Camera: Topcon TRC-NW400; 30° FOV; 2212 by 1661 pixels; optic disc at the center of the field; CFP — 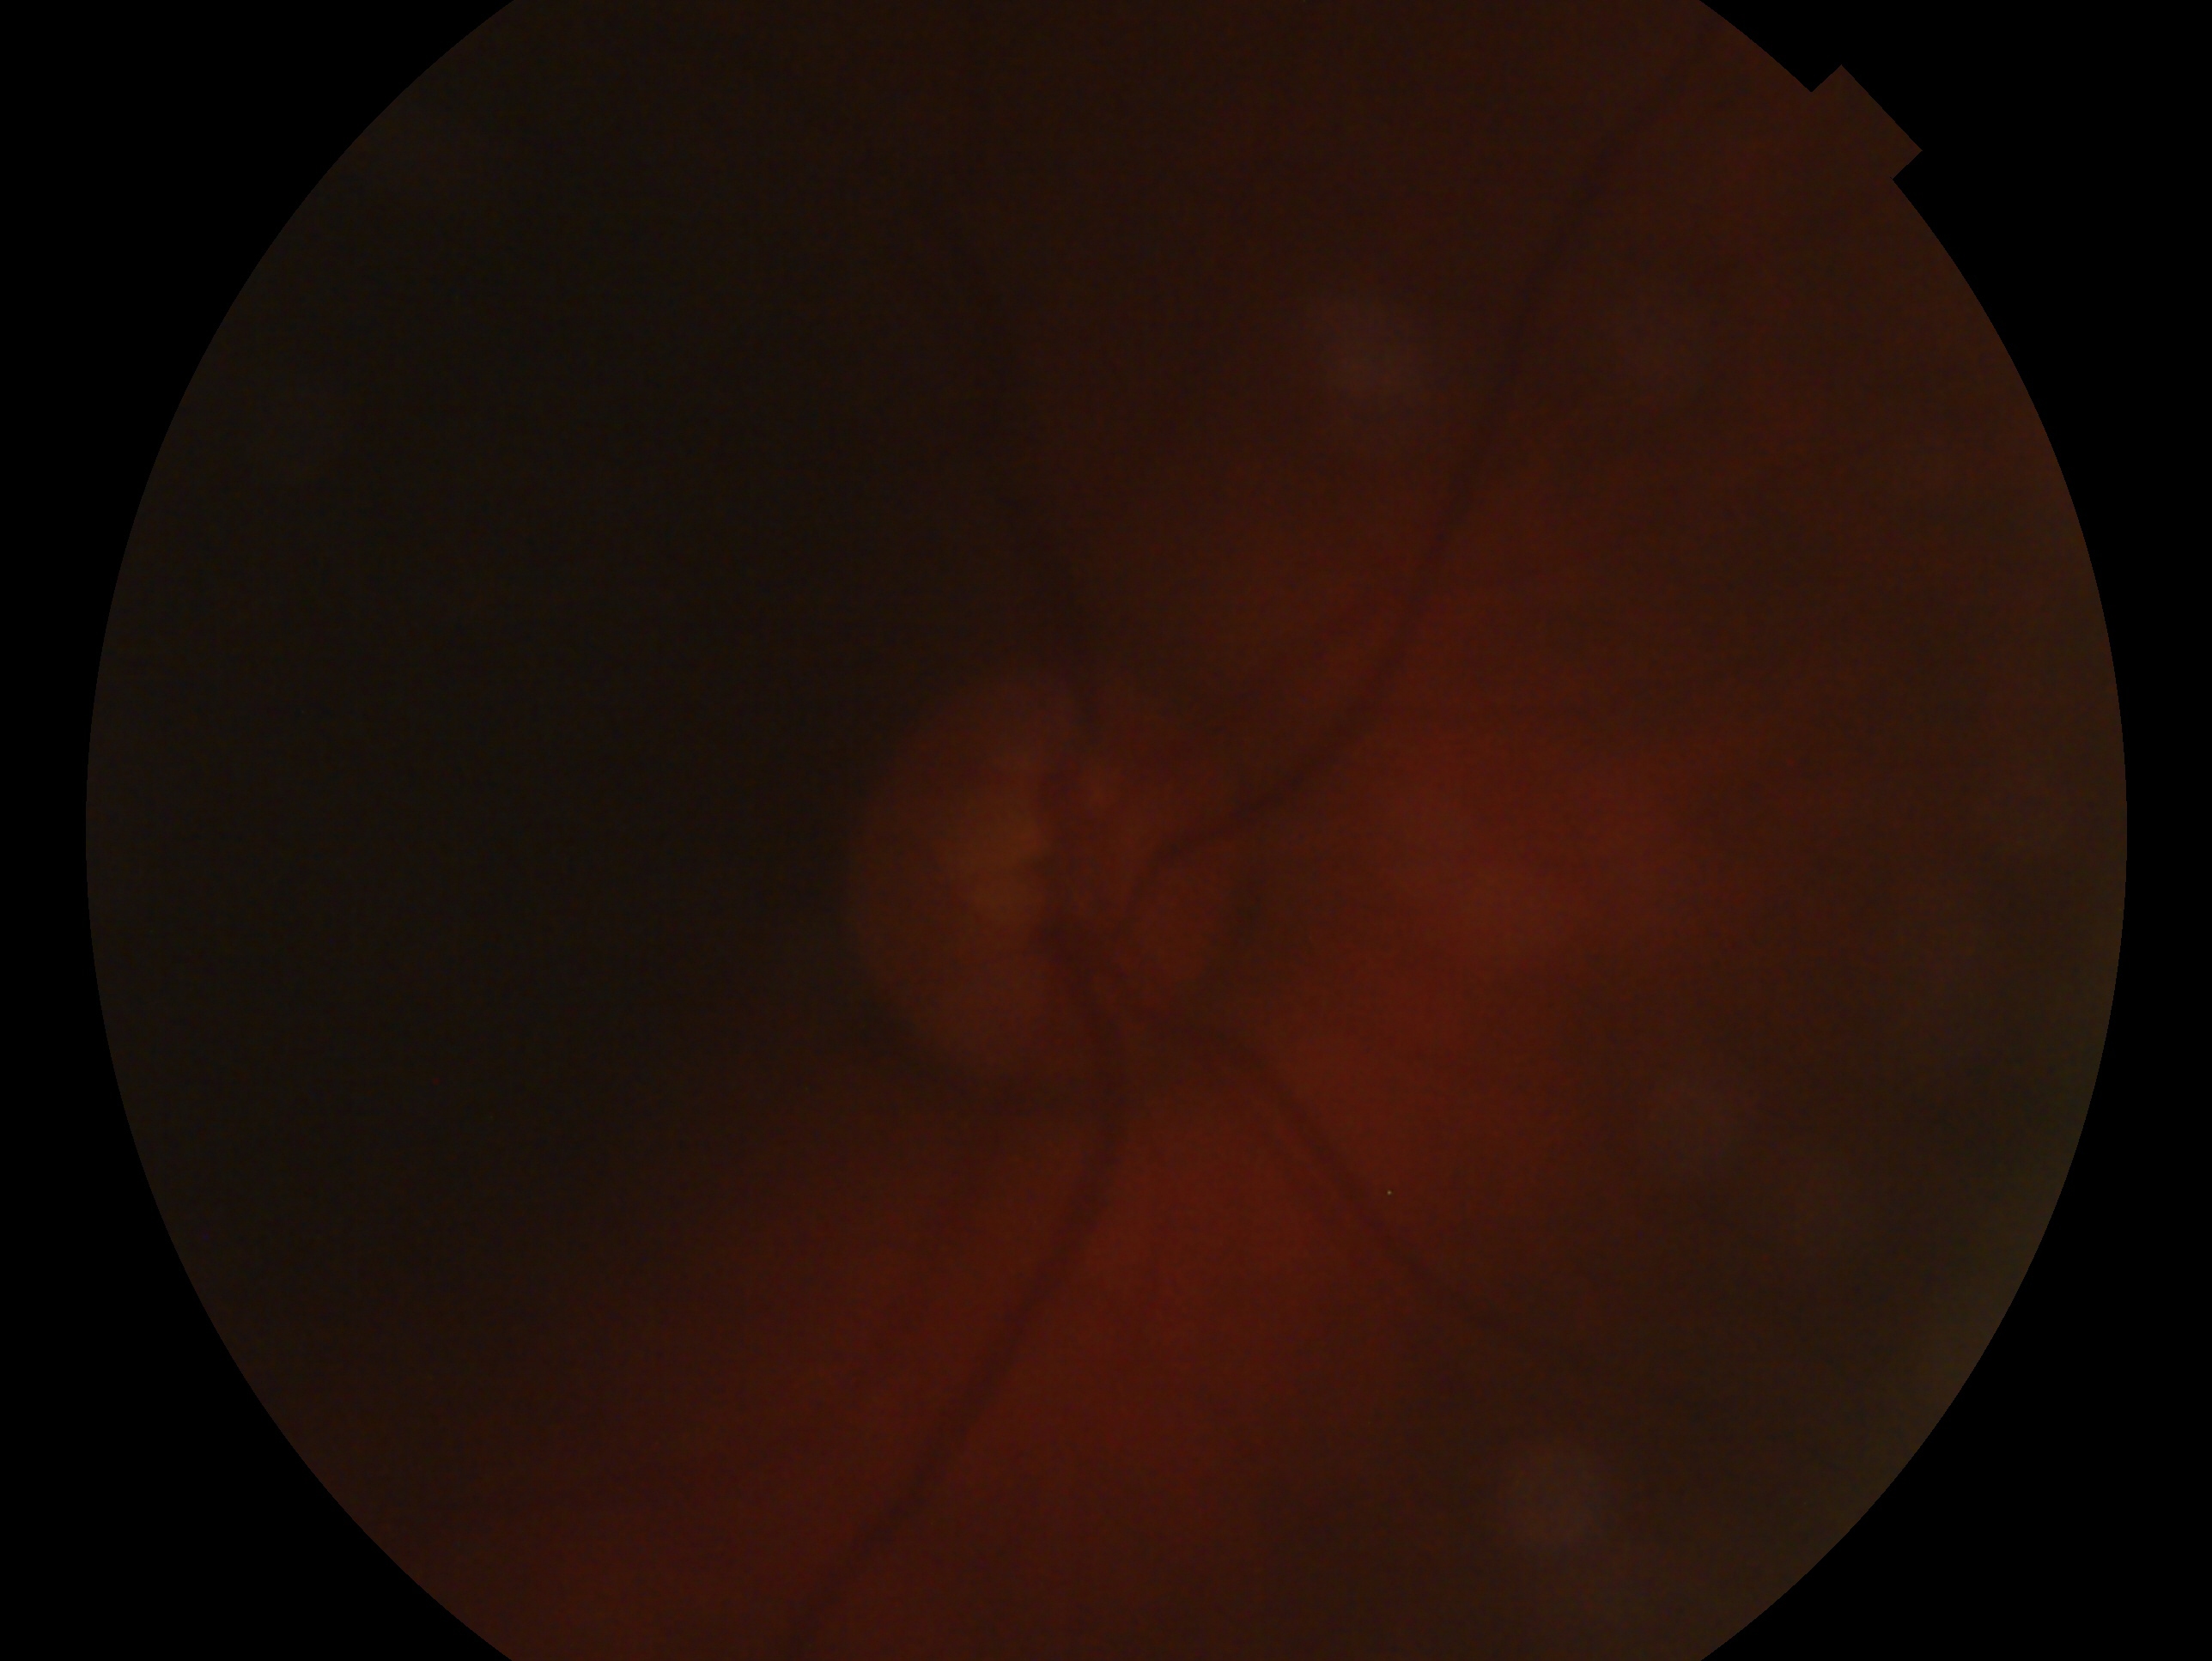 {"eye": "oculus dexter", "glaucoma_dx": "no evidence of glaucoma"}